Wide-field fundus photograph from neonatal ROP screening:
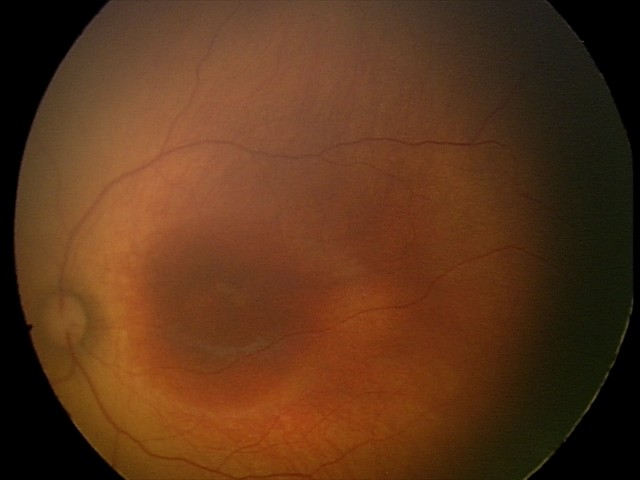 Finding: no abnormalities.